Posterior pole photograph, without pupil dilation, FOV: 45 degrees, 848 x 848 pixels:
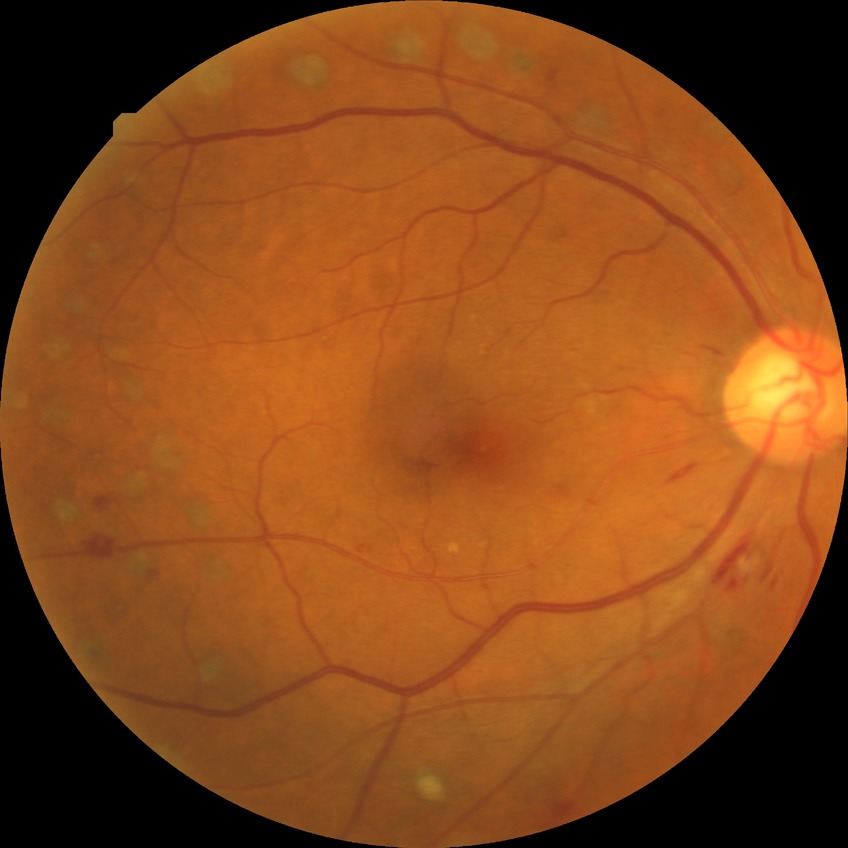

Diabetic retinopathy (DR) is proliferative diabetic retinopathy (PDR).